Wide-field fundus image from infant ROP screening: 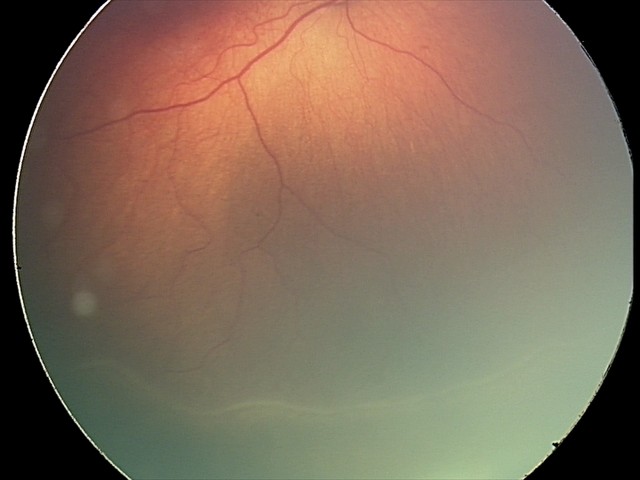

ROP = stage 2 — ridge with height and width at the demarcation line
plus form = absent